Fundus photo: 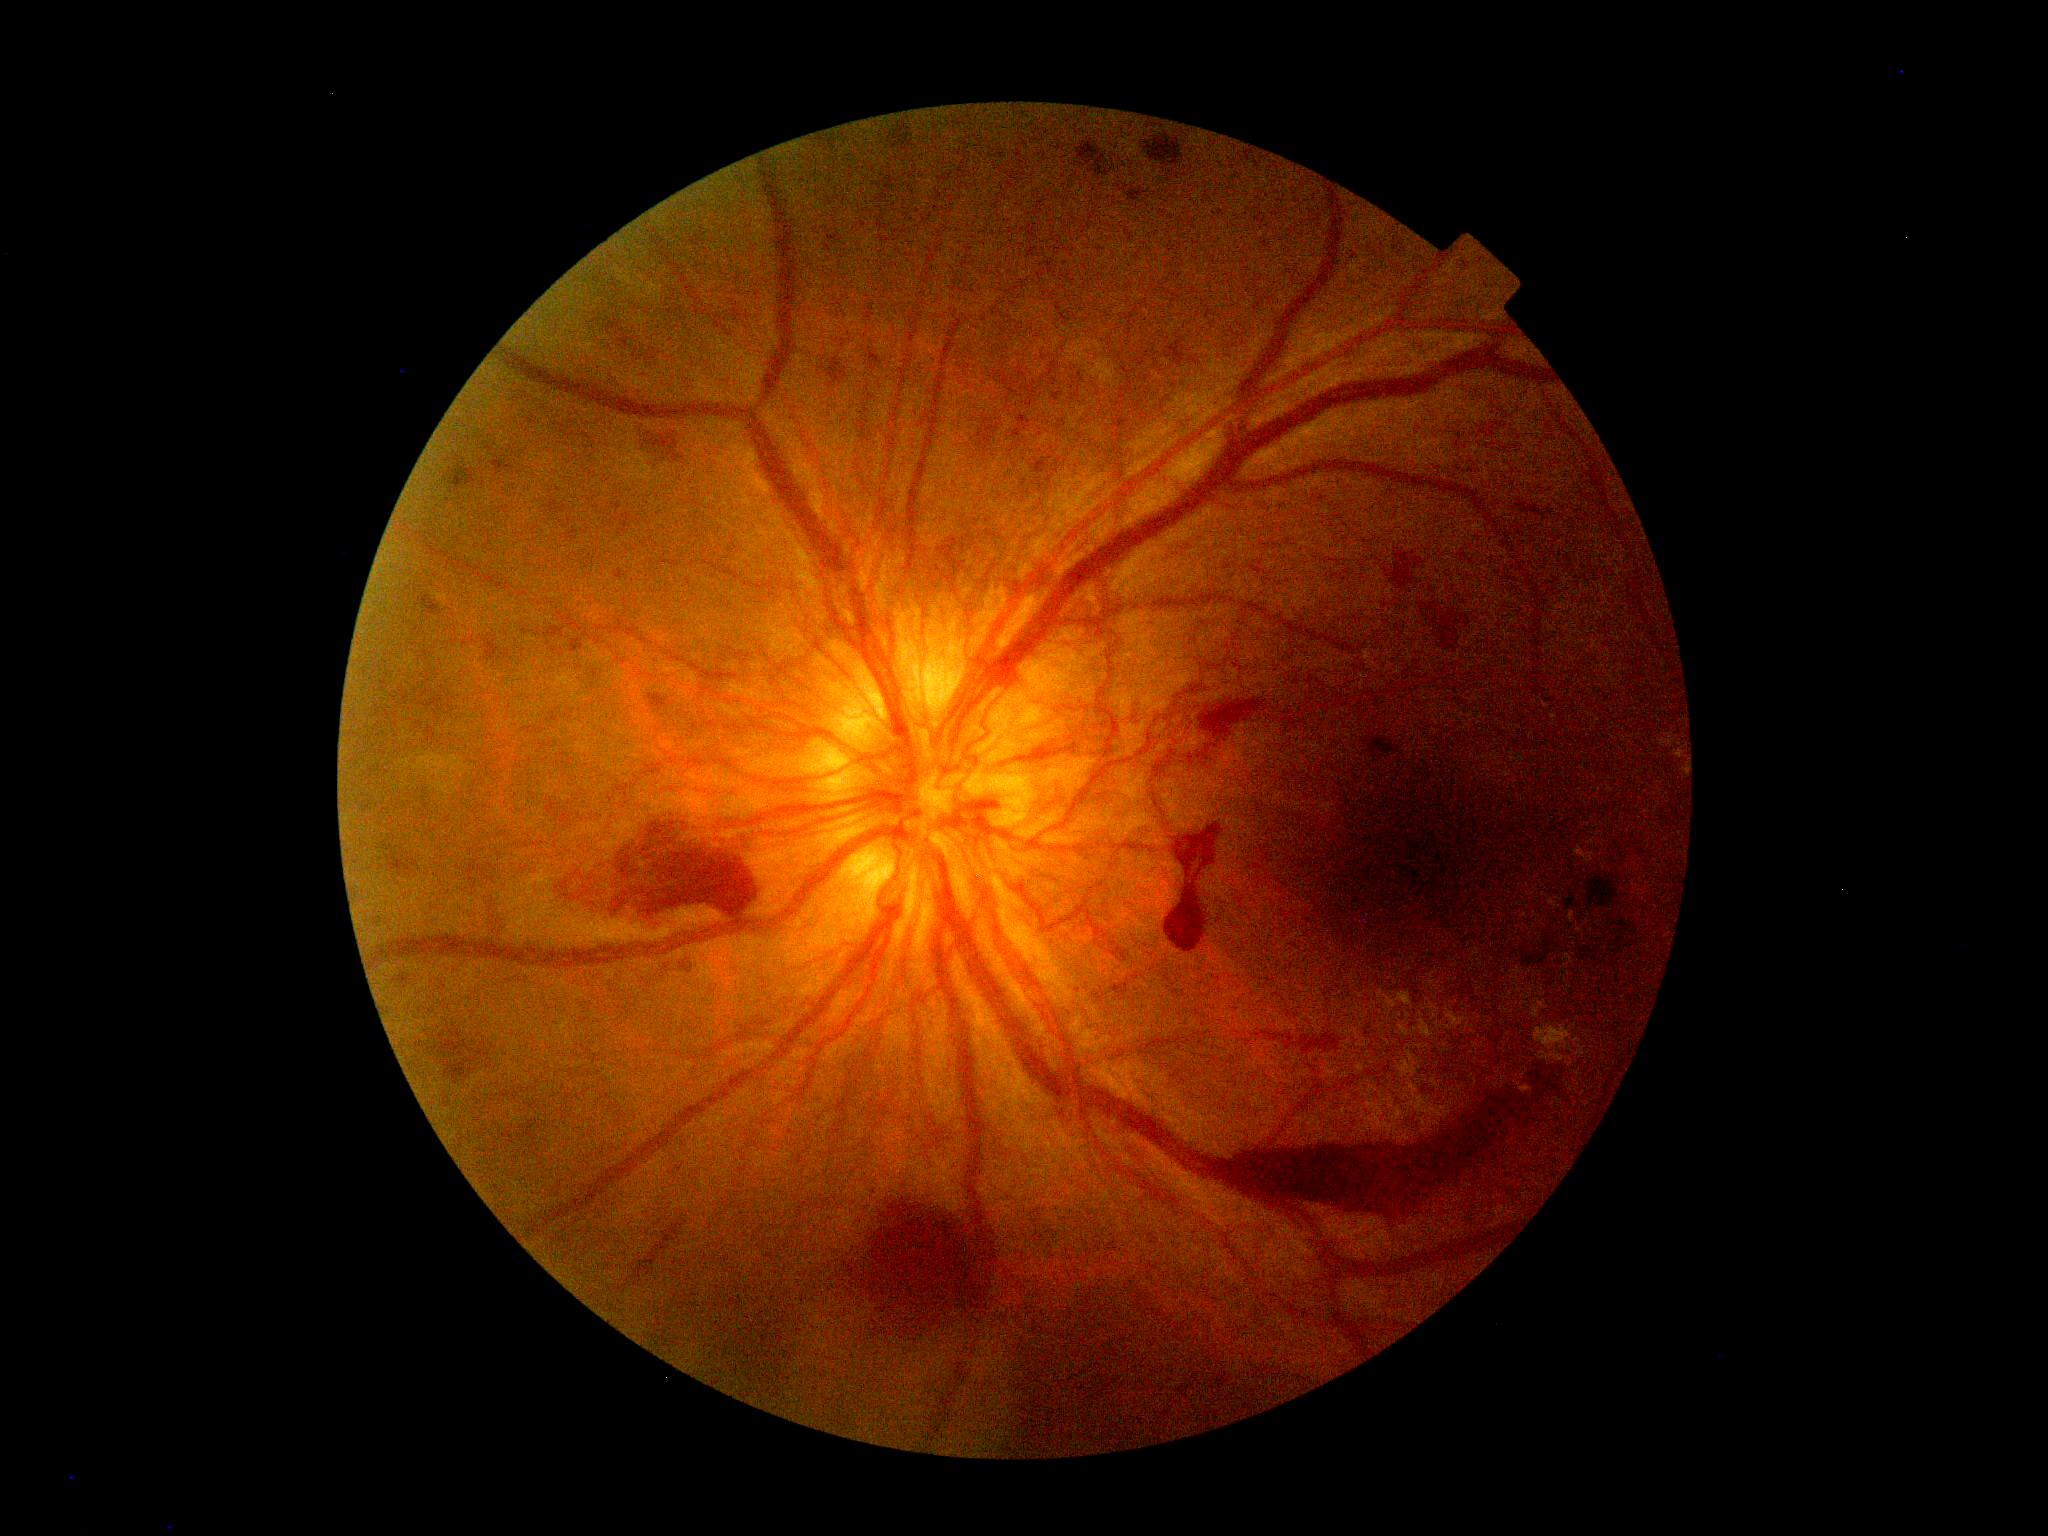
{
  "dr_grade": "grade 4 (PDR)"
}